45° FOV, tabletop color fundus camera image
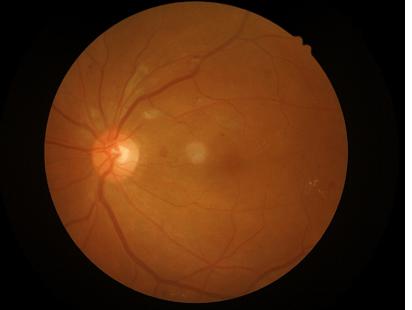 Quality assessment:
- overall: satisfactory
- contrast: good
- illumination: satisfactory
- sharpness: clear